Modified Davis grading: 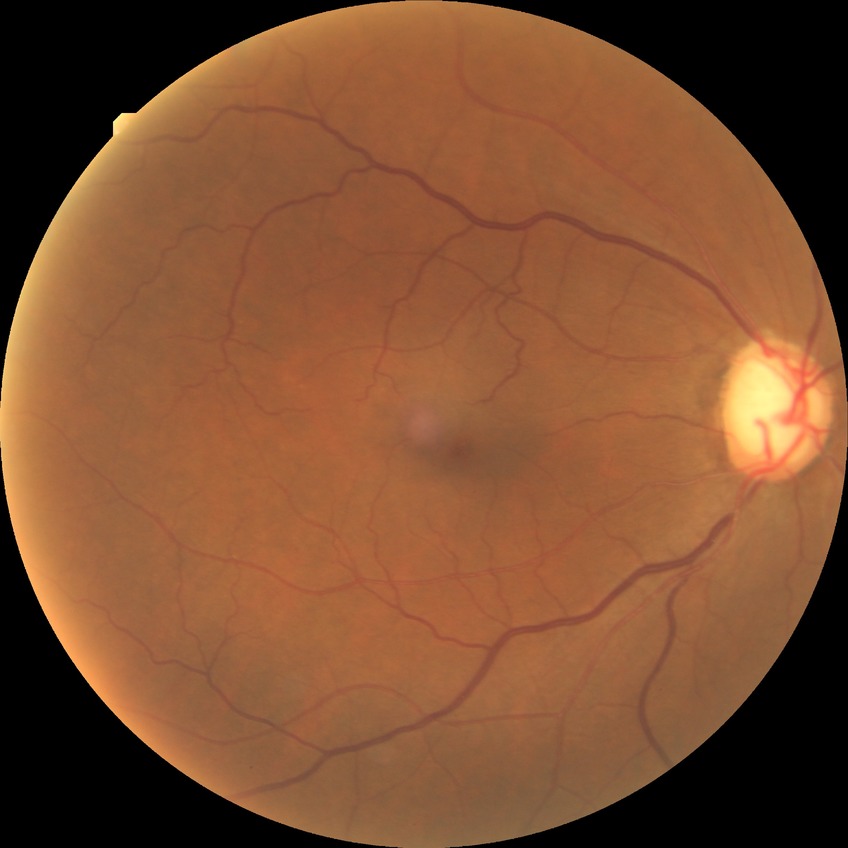
diabetic retinopathy (DR): NDR (no diabetic retinopathy).